Infant wide-field retinal image; 640x480
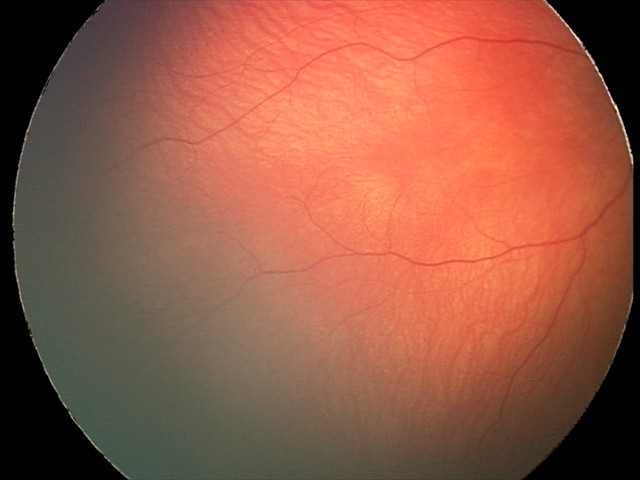
Examination with physiological retinal findings.